Modified Davis grading; image size 848x848 — 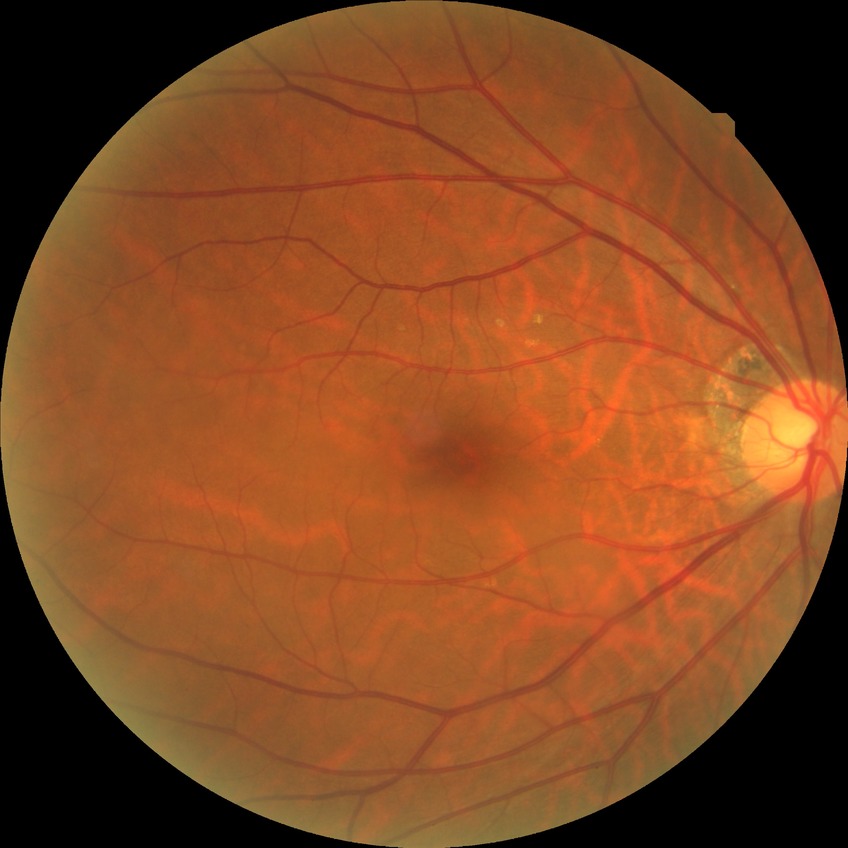

{
  "davis_grade": "no diabetic retinopathy"
}